Infant wide-field fundus photograph · captured with the Natus RetCam Envision (130° field of view) · image size 1440x1080
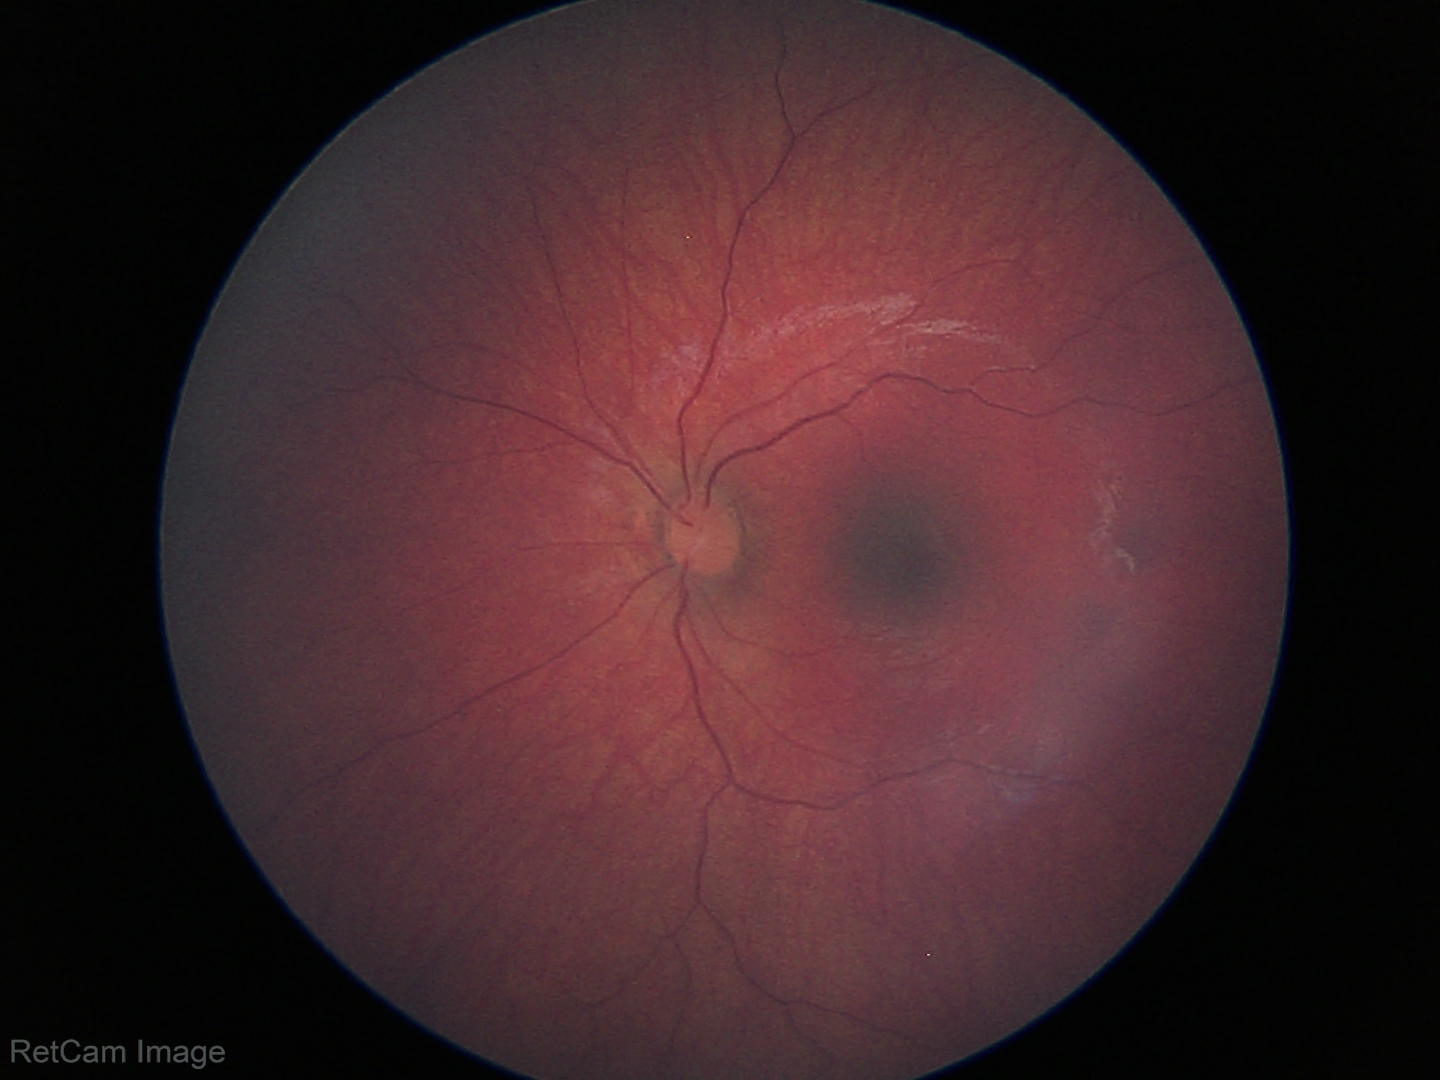
Finding = no pathology identified